DR severity per modified Davis staging.
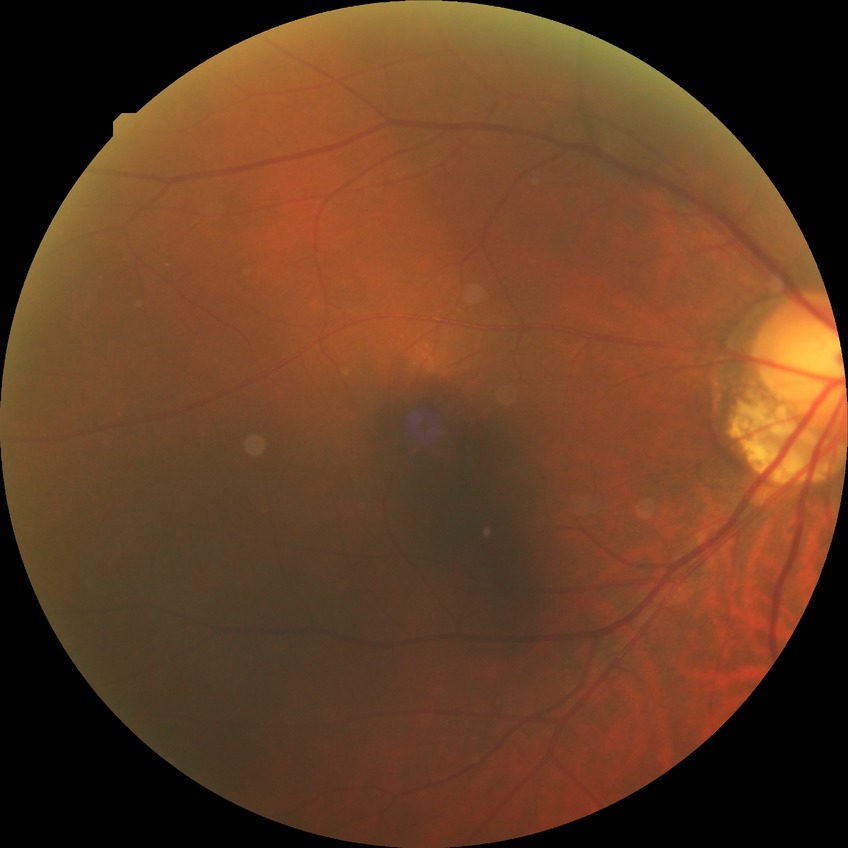 Diabetic retinopathy grade is no diabetic retinopathy.